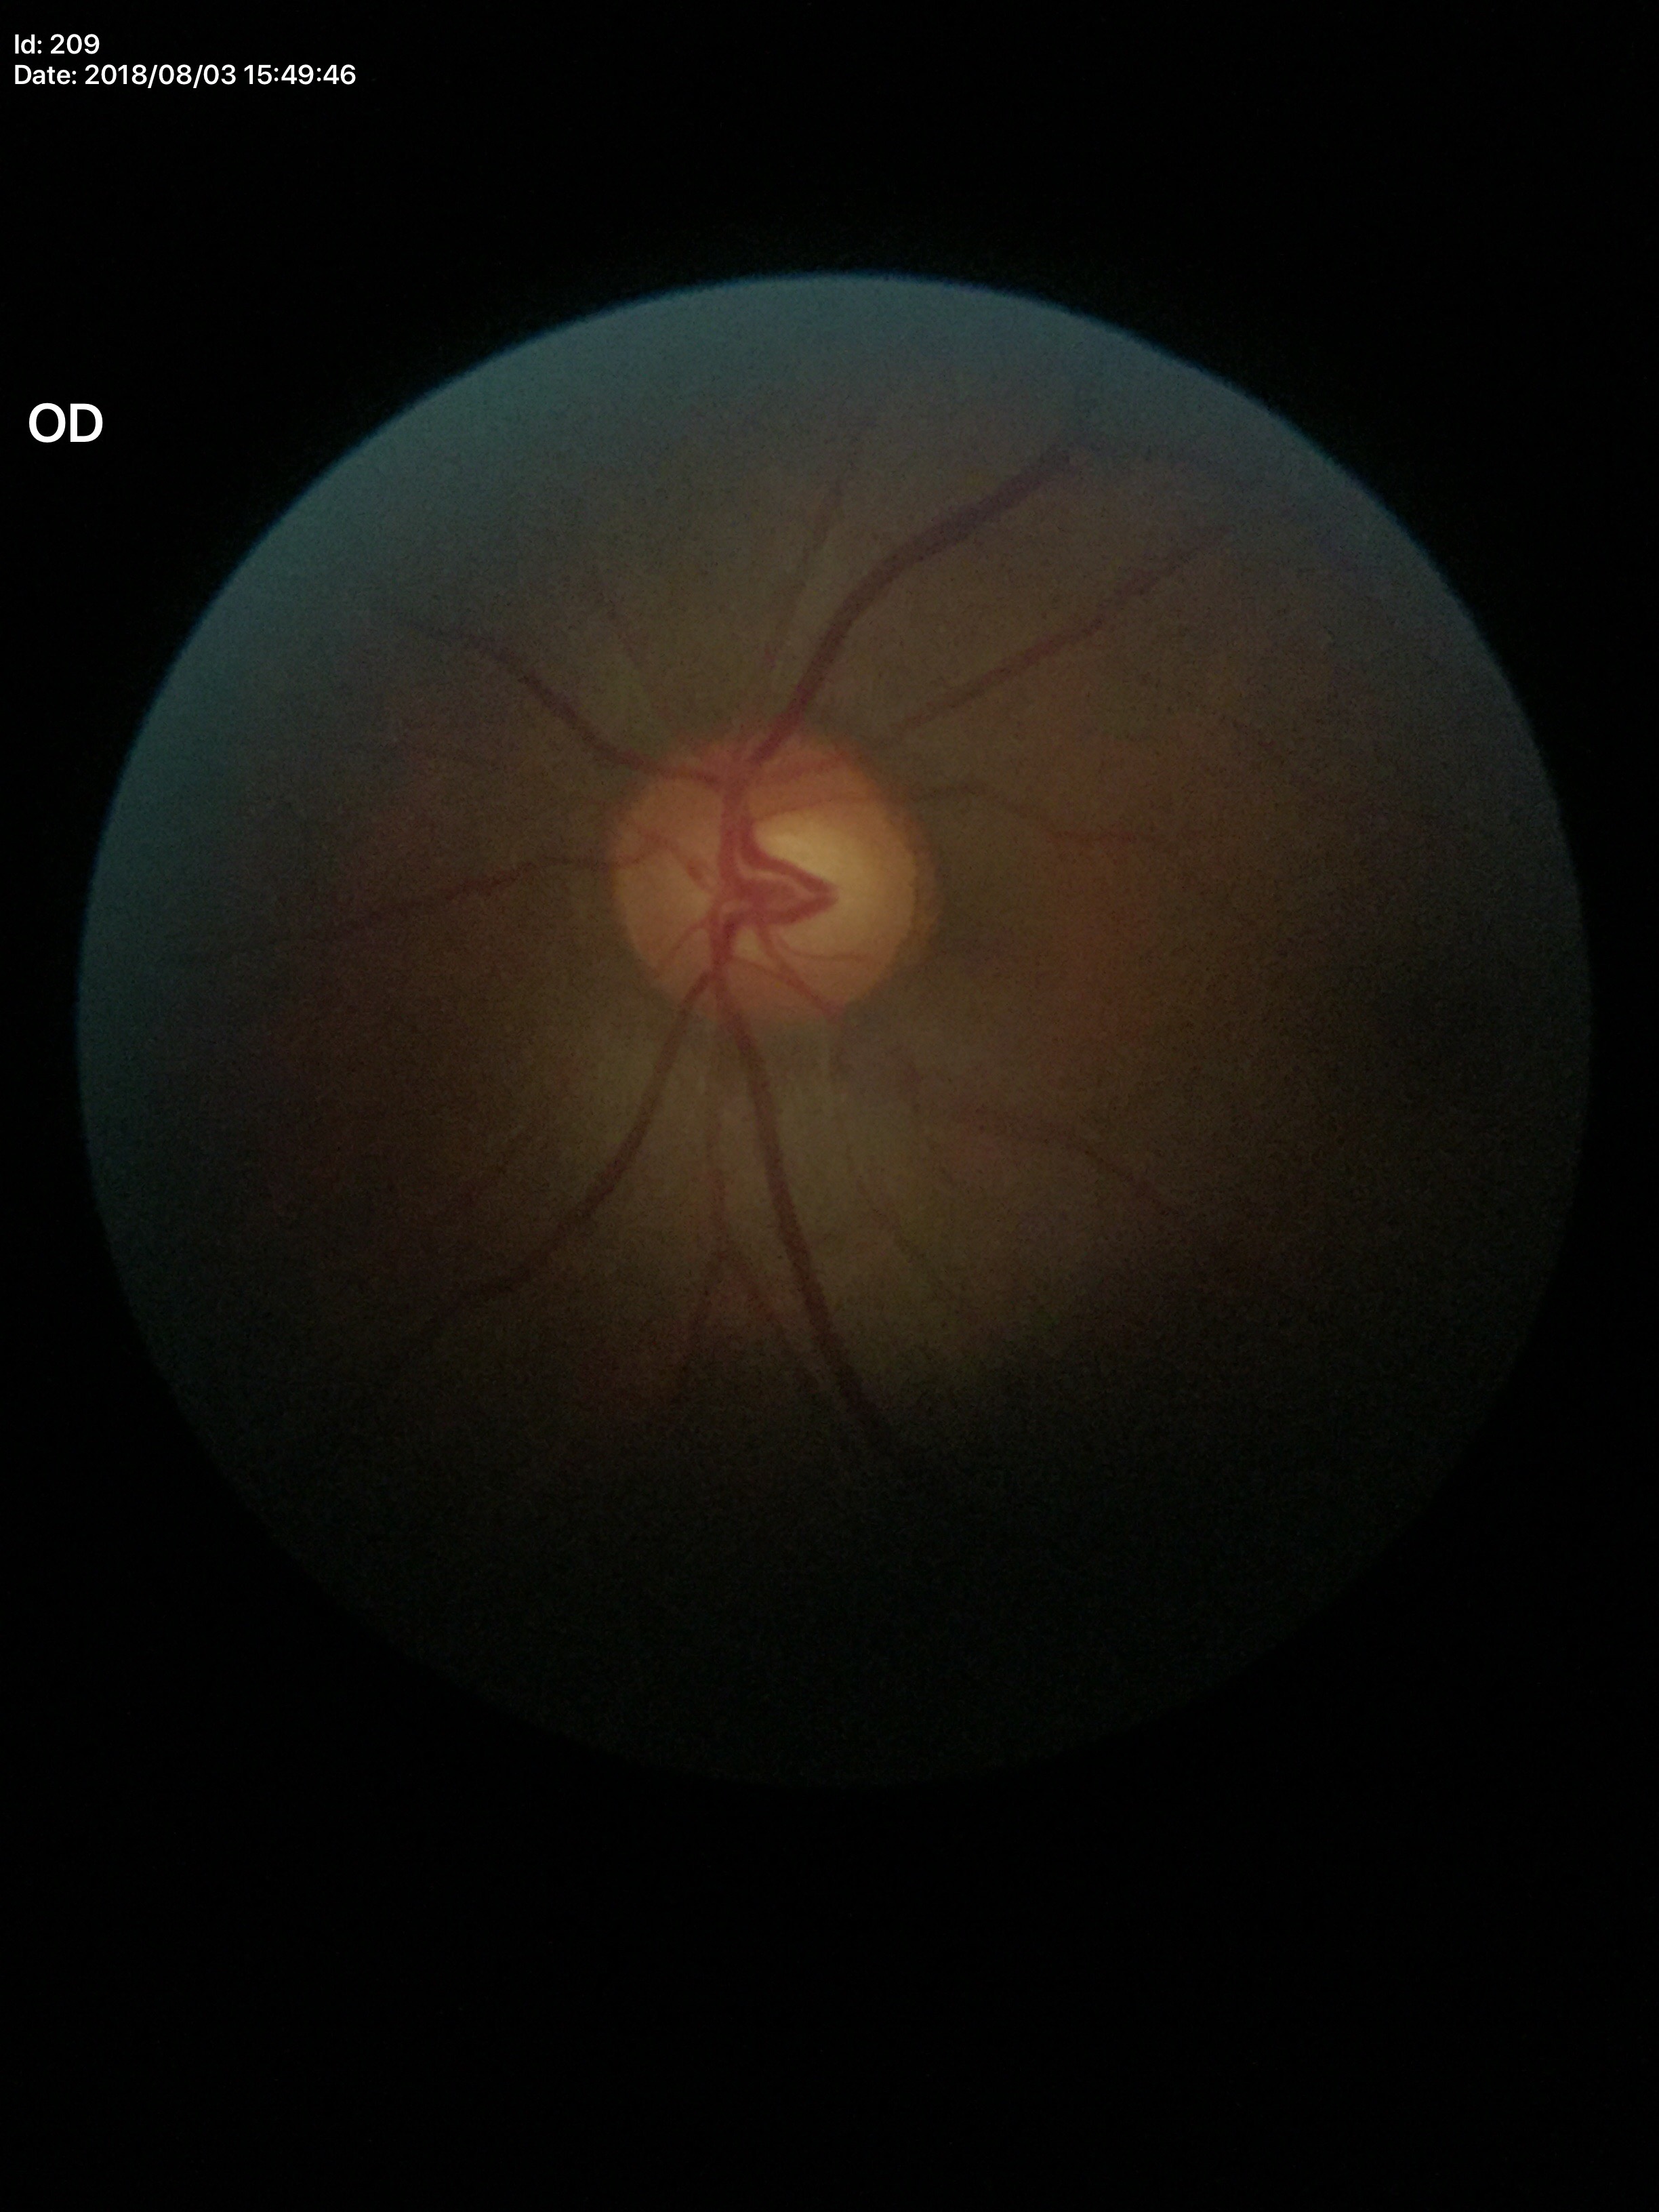 Glaucoma screening: no suspicious findings.
VCDR of 0.57.